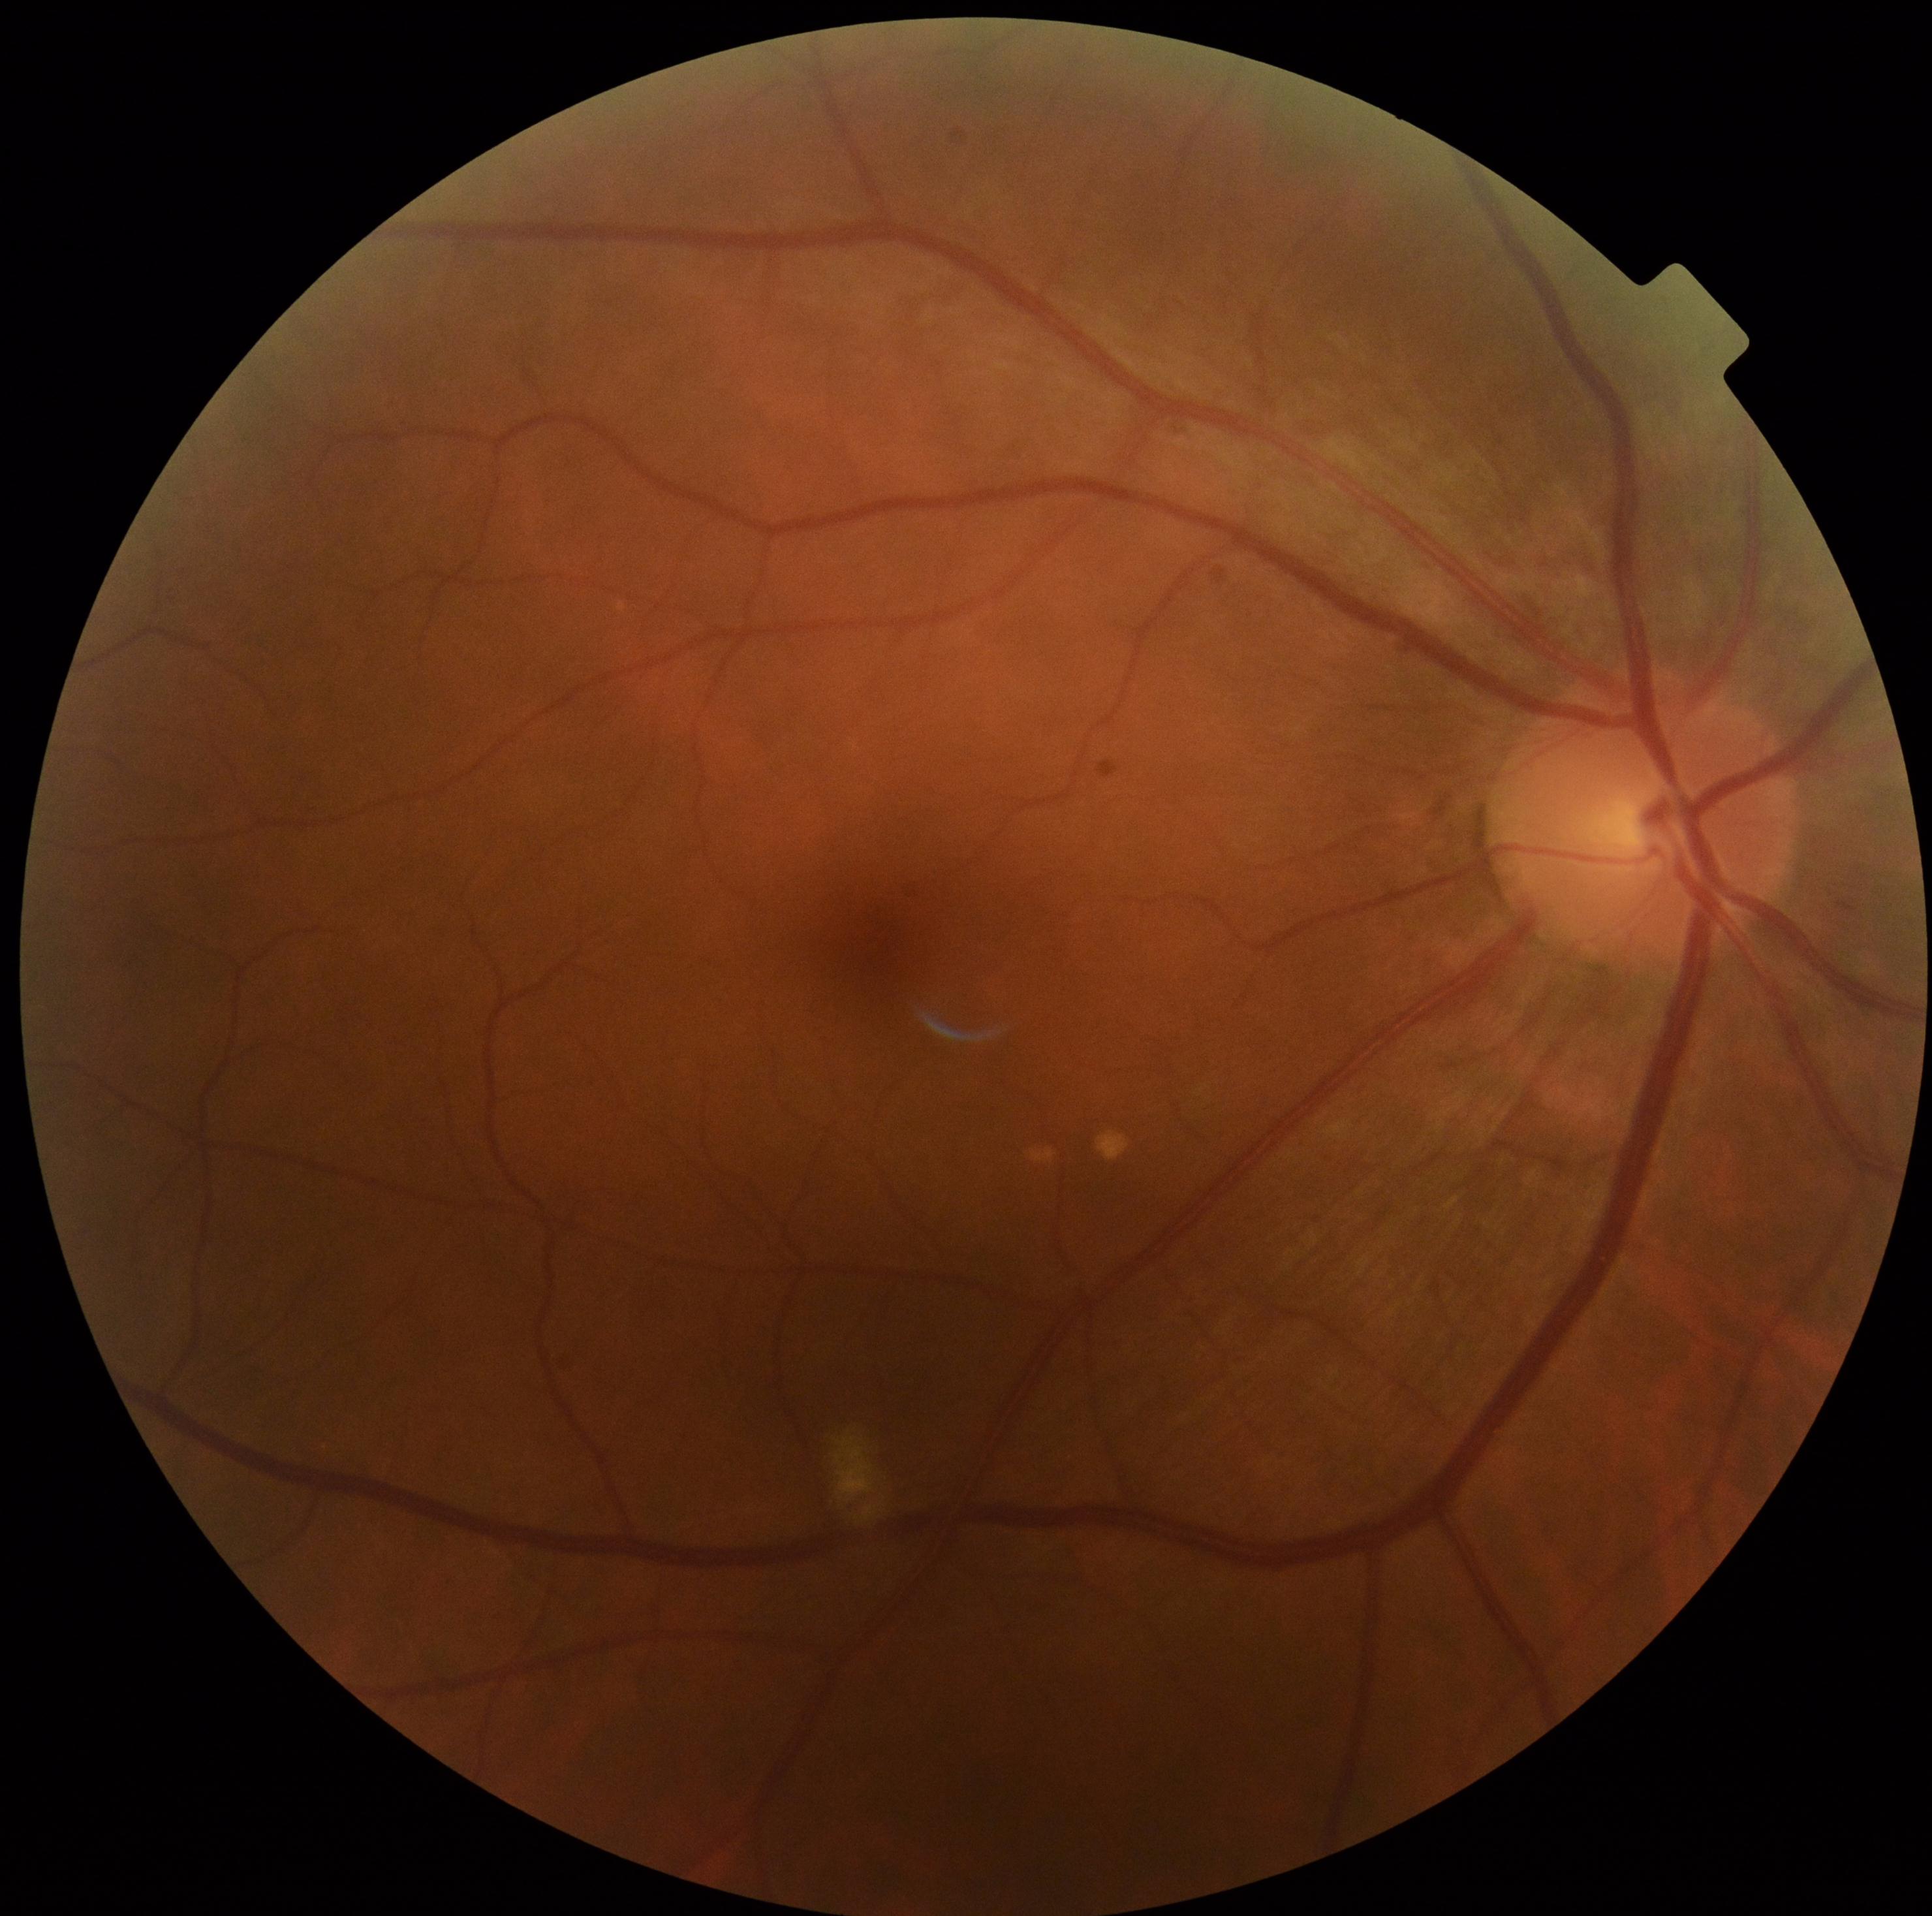
DR: grade 2.